Fundus photo. Image size 1659x2212. Captured on a Remidio smartphone fundus camera
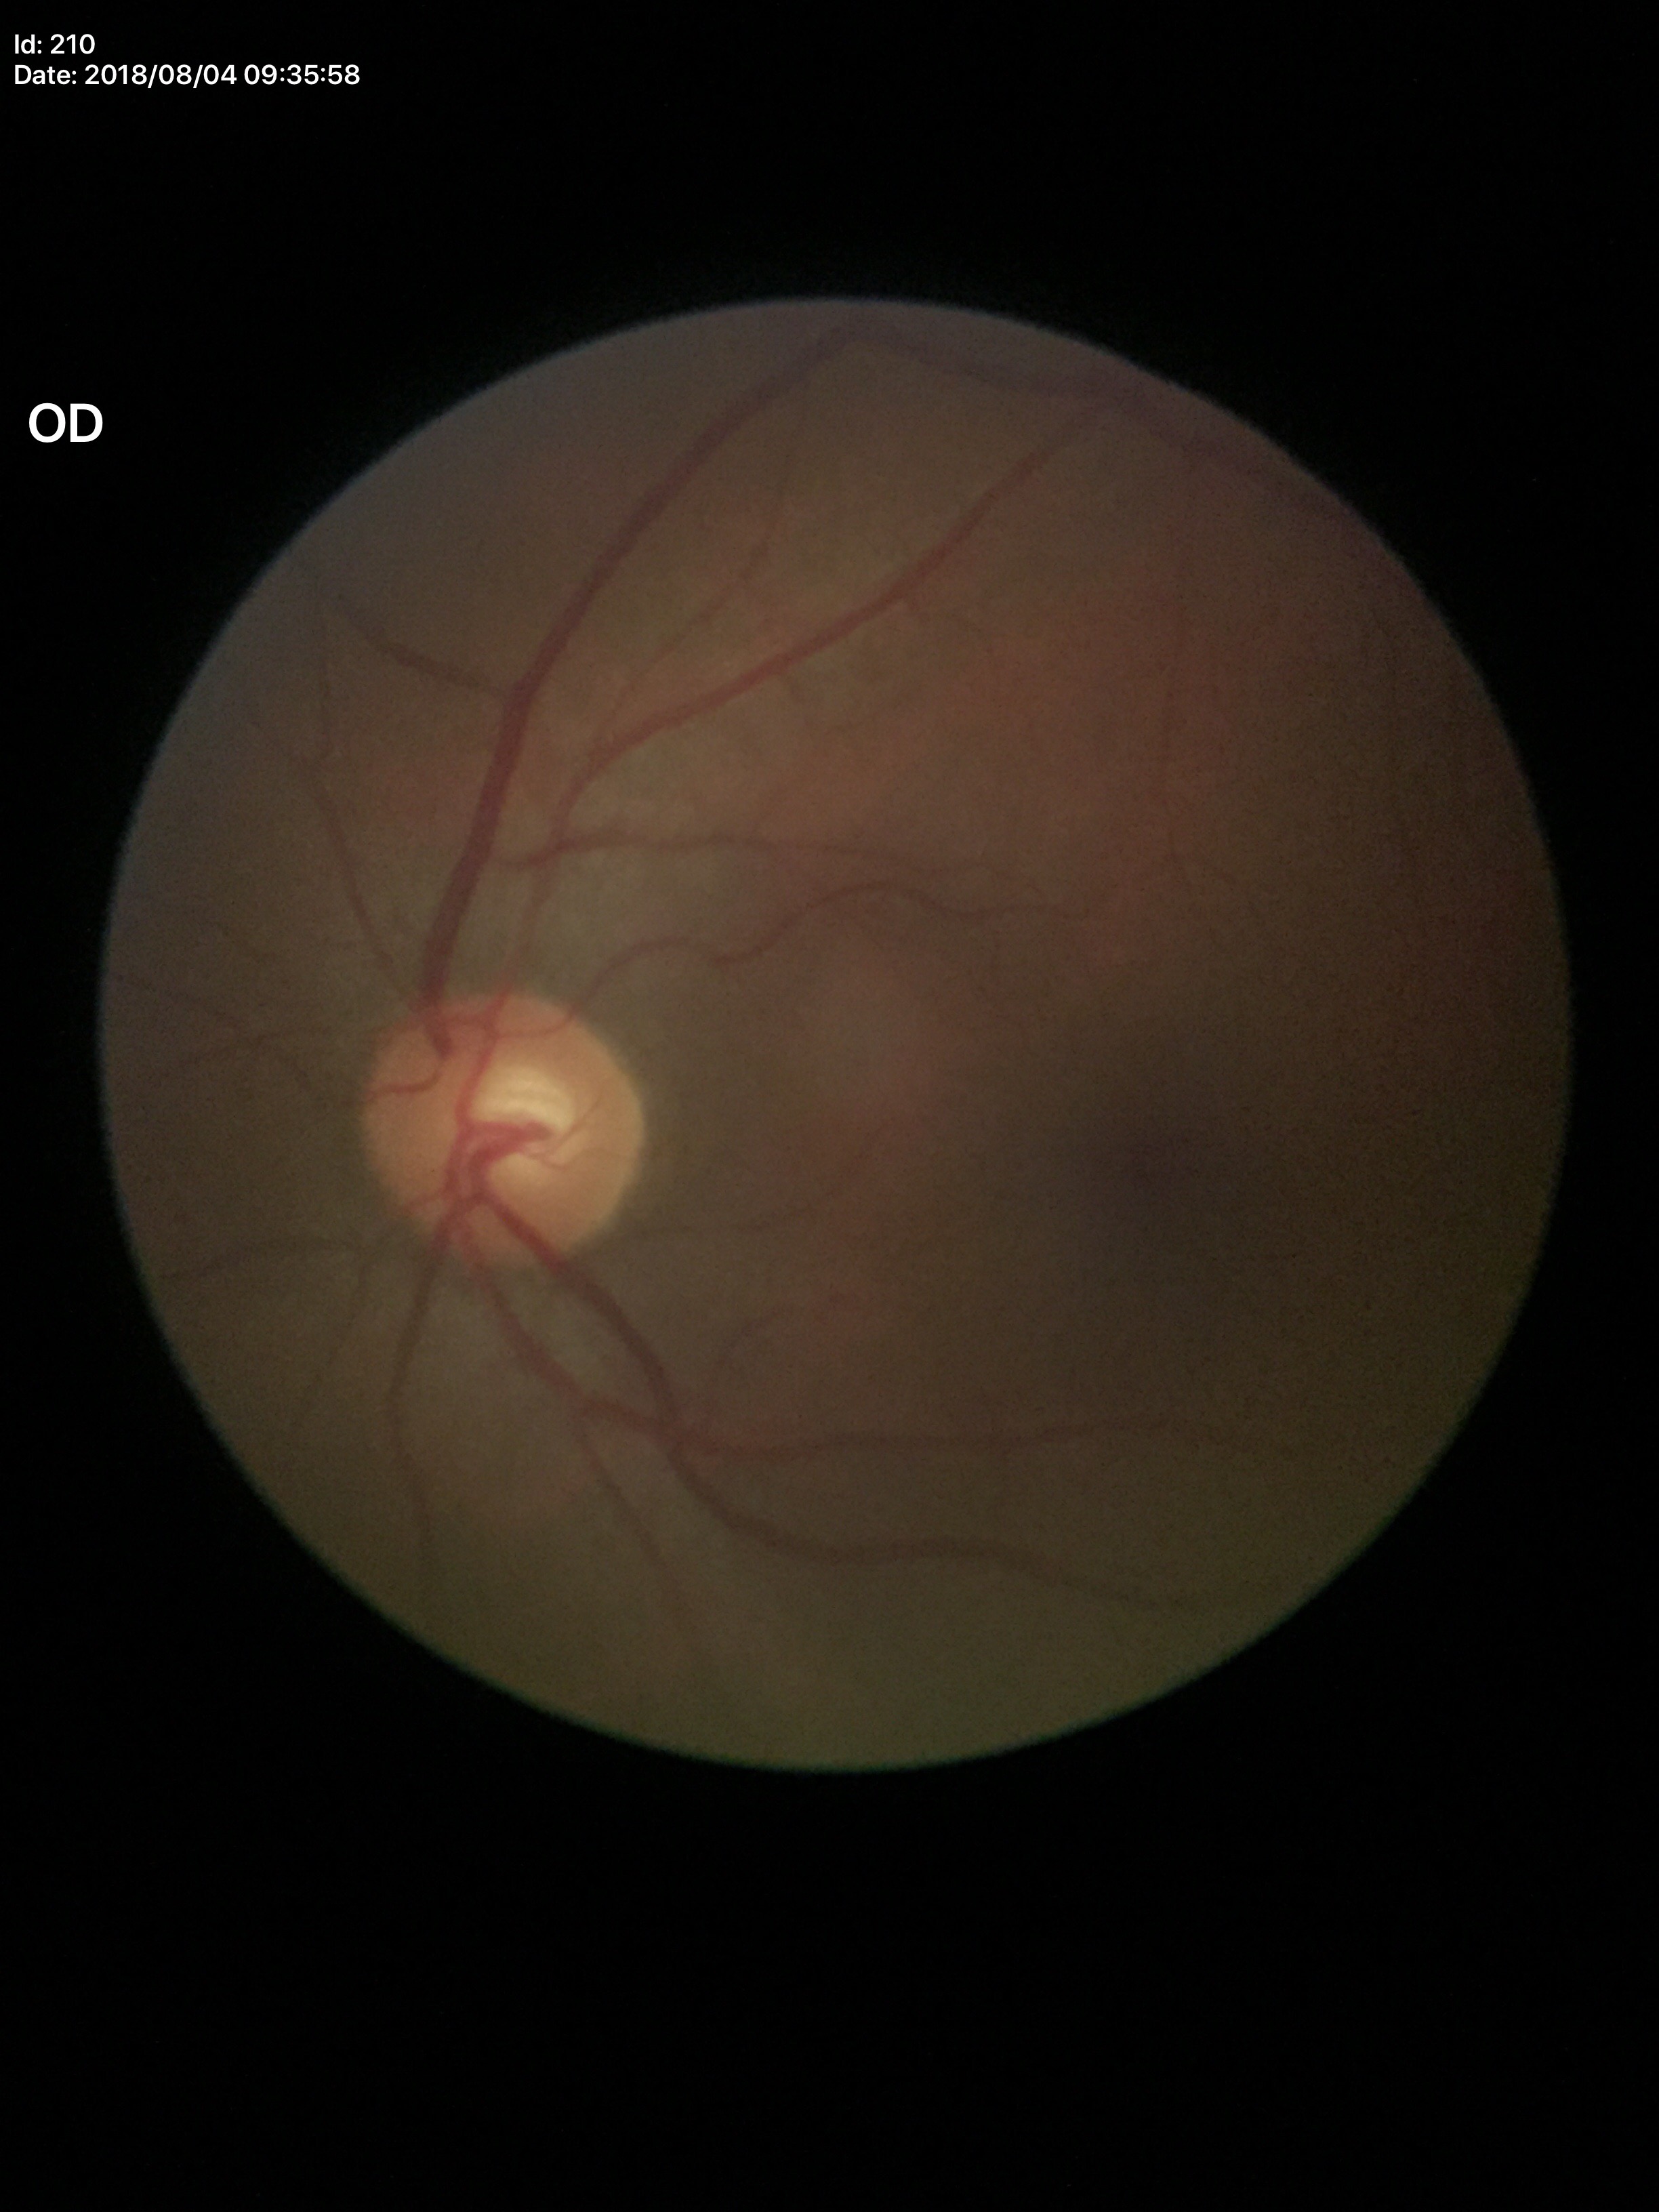
Horizontal CDR of 0.54. Glaucoma decision: not suspect. Vertical cup-to-disc ratio of 0.50.